Gender: F. Central corneal thickness: 546 µm. Age 47. Axial length (AL): 22.23 mm. Intraocular pressure (IOP) by non-contact tonometry: 19 mmHg
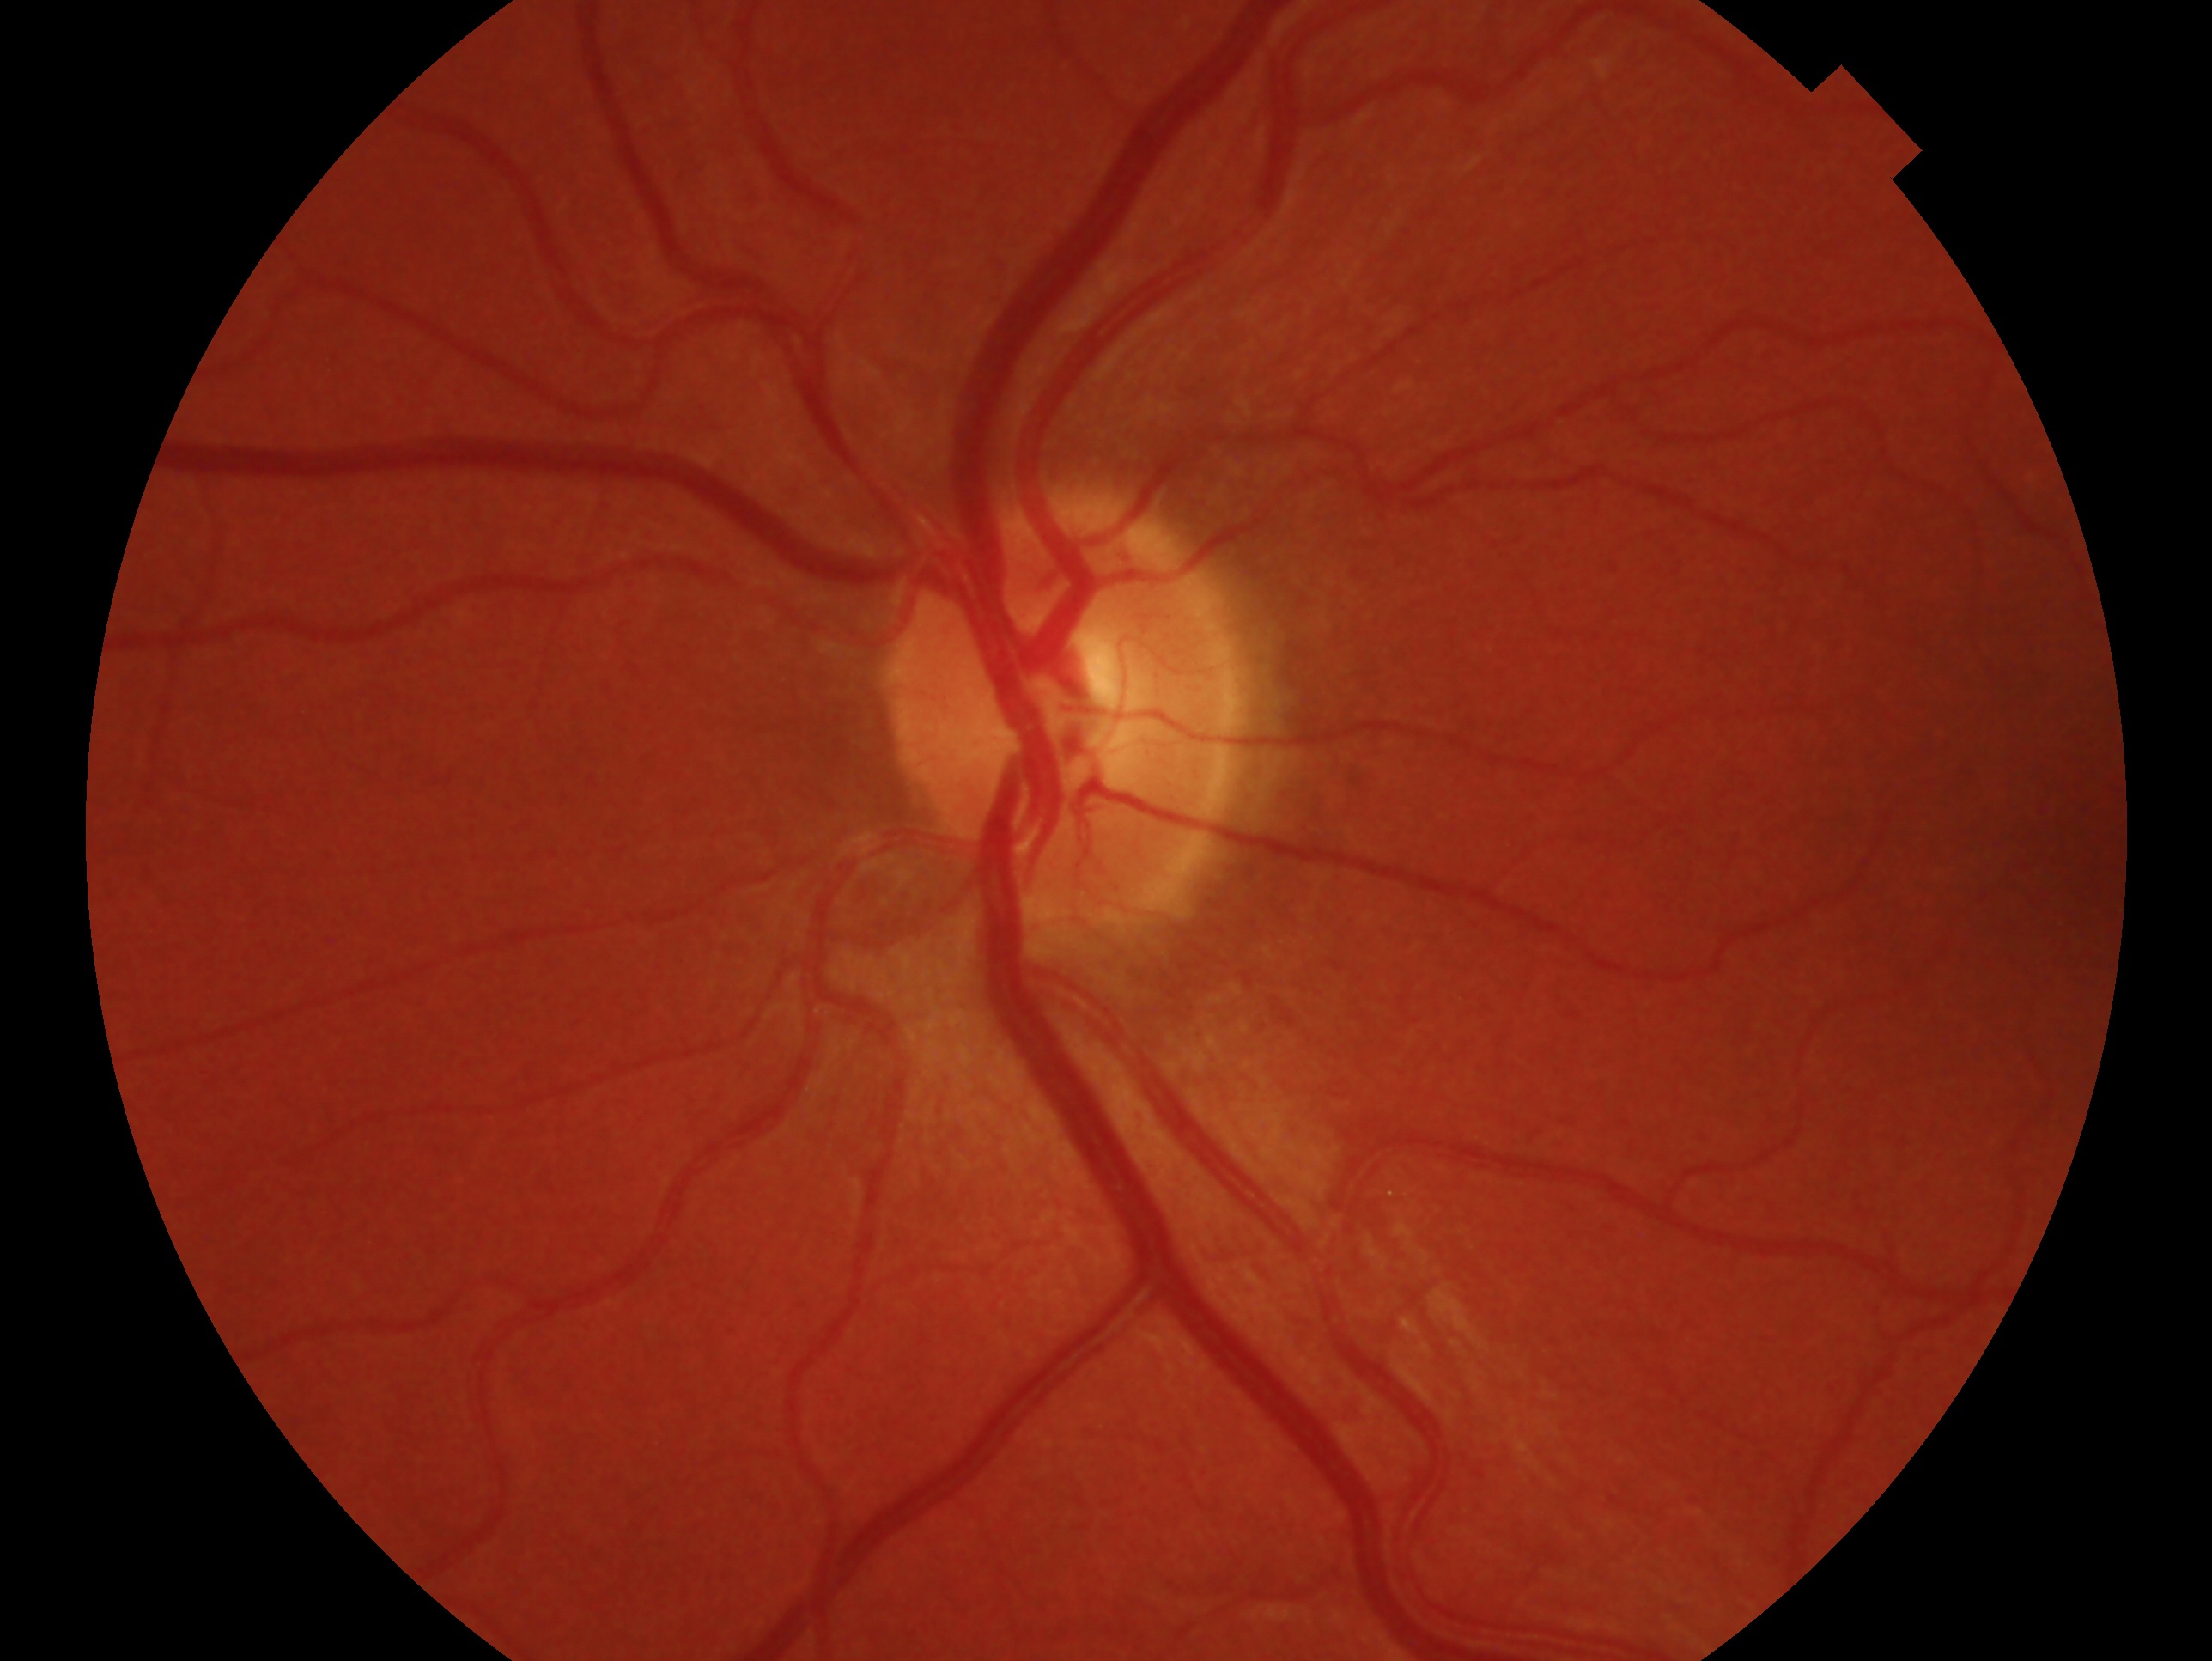
Glaucoma diagnosis — negative for glaucoma. Eye: OS.